Fundus photo.
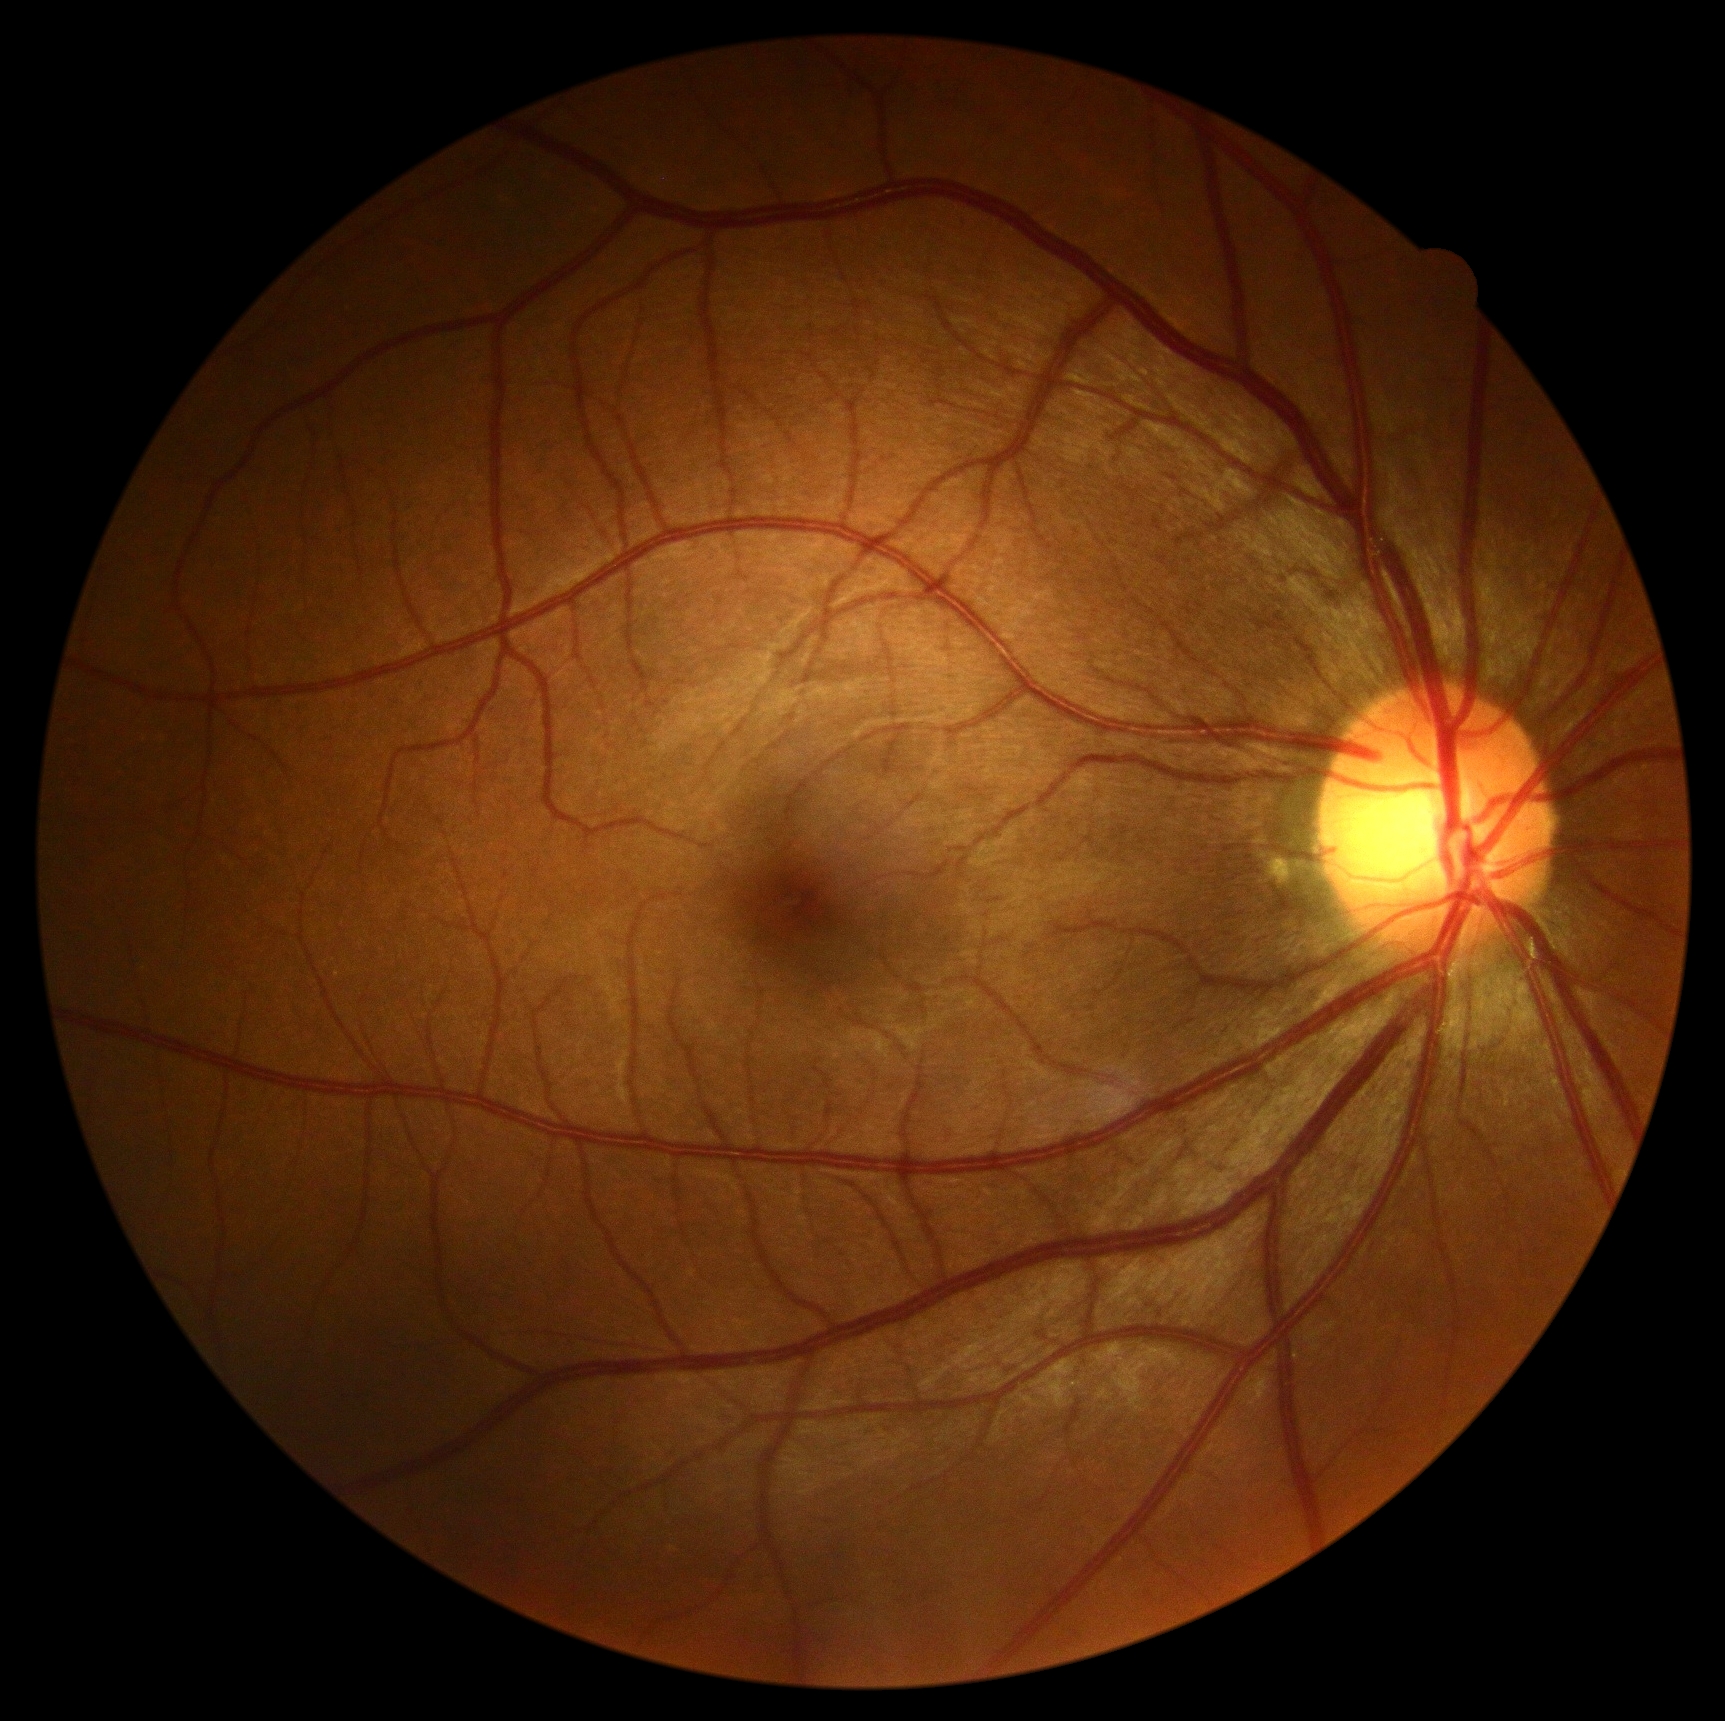
DR severity@no apparent diabetic retinopathy (grade 0), DR impression@negative for DR.